Color fundus image:
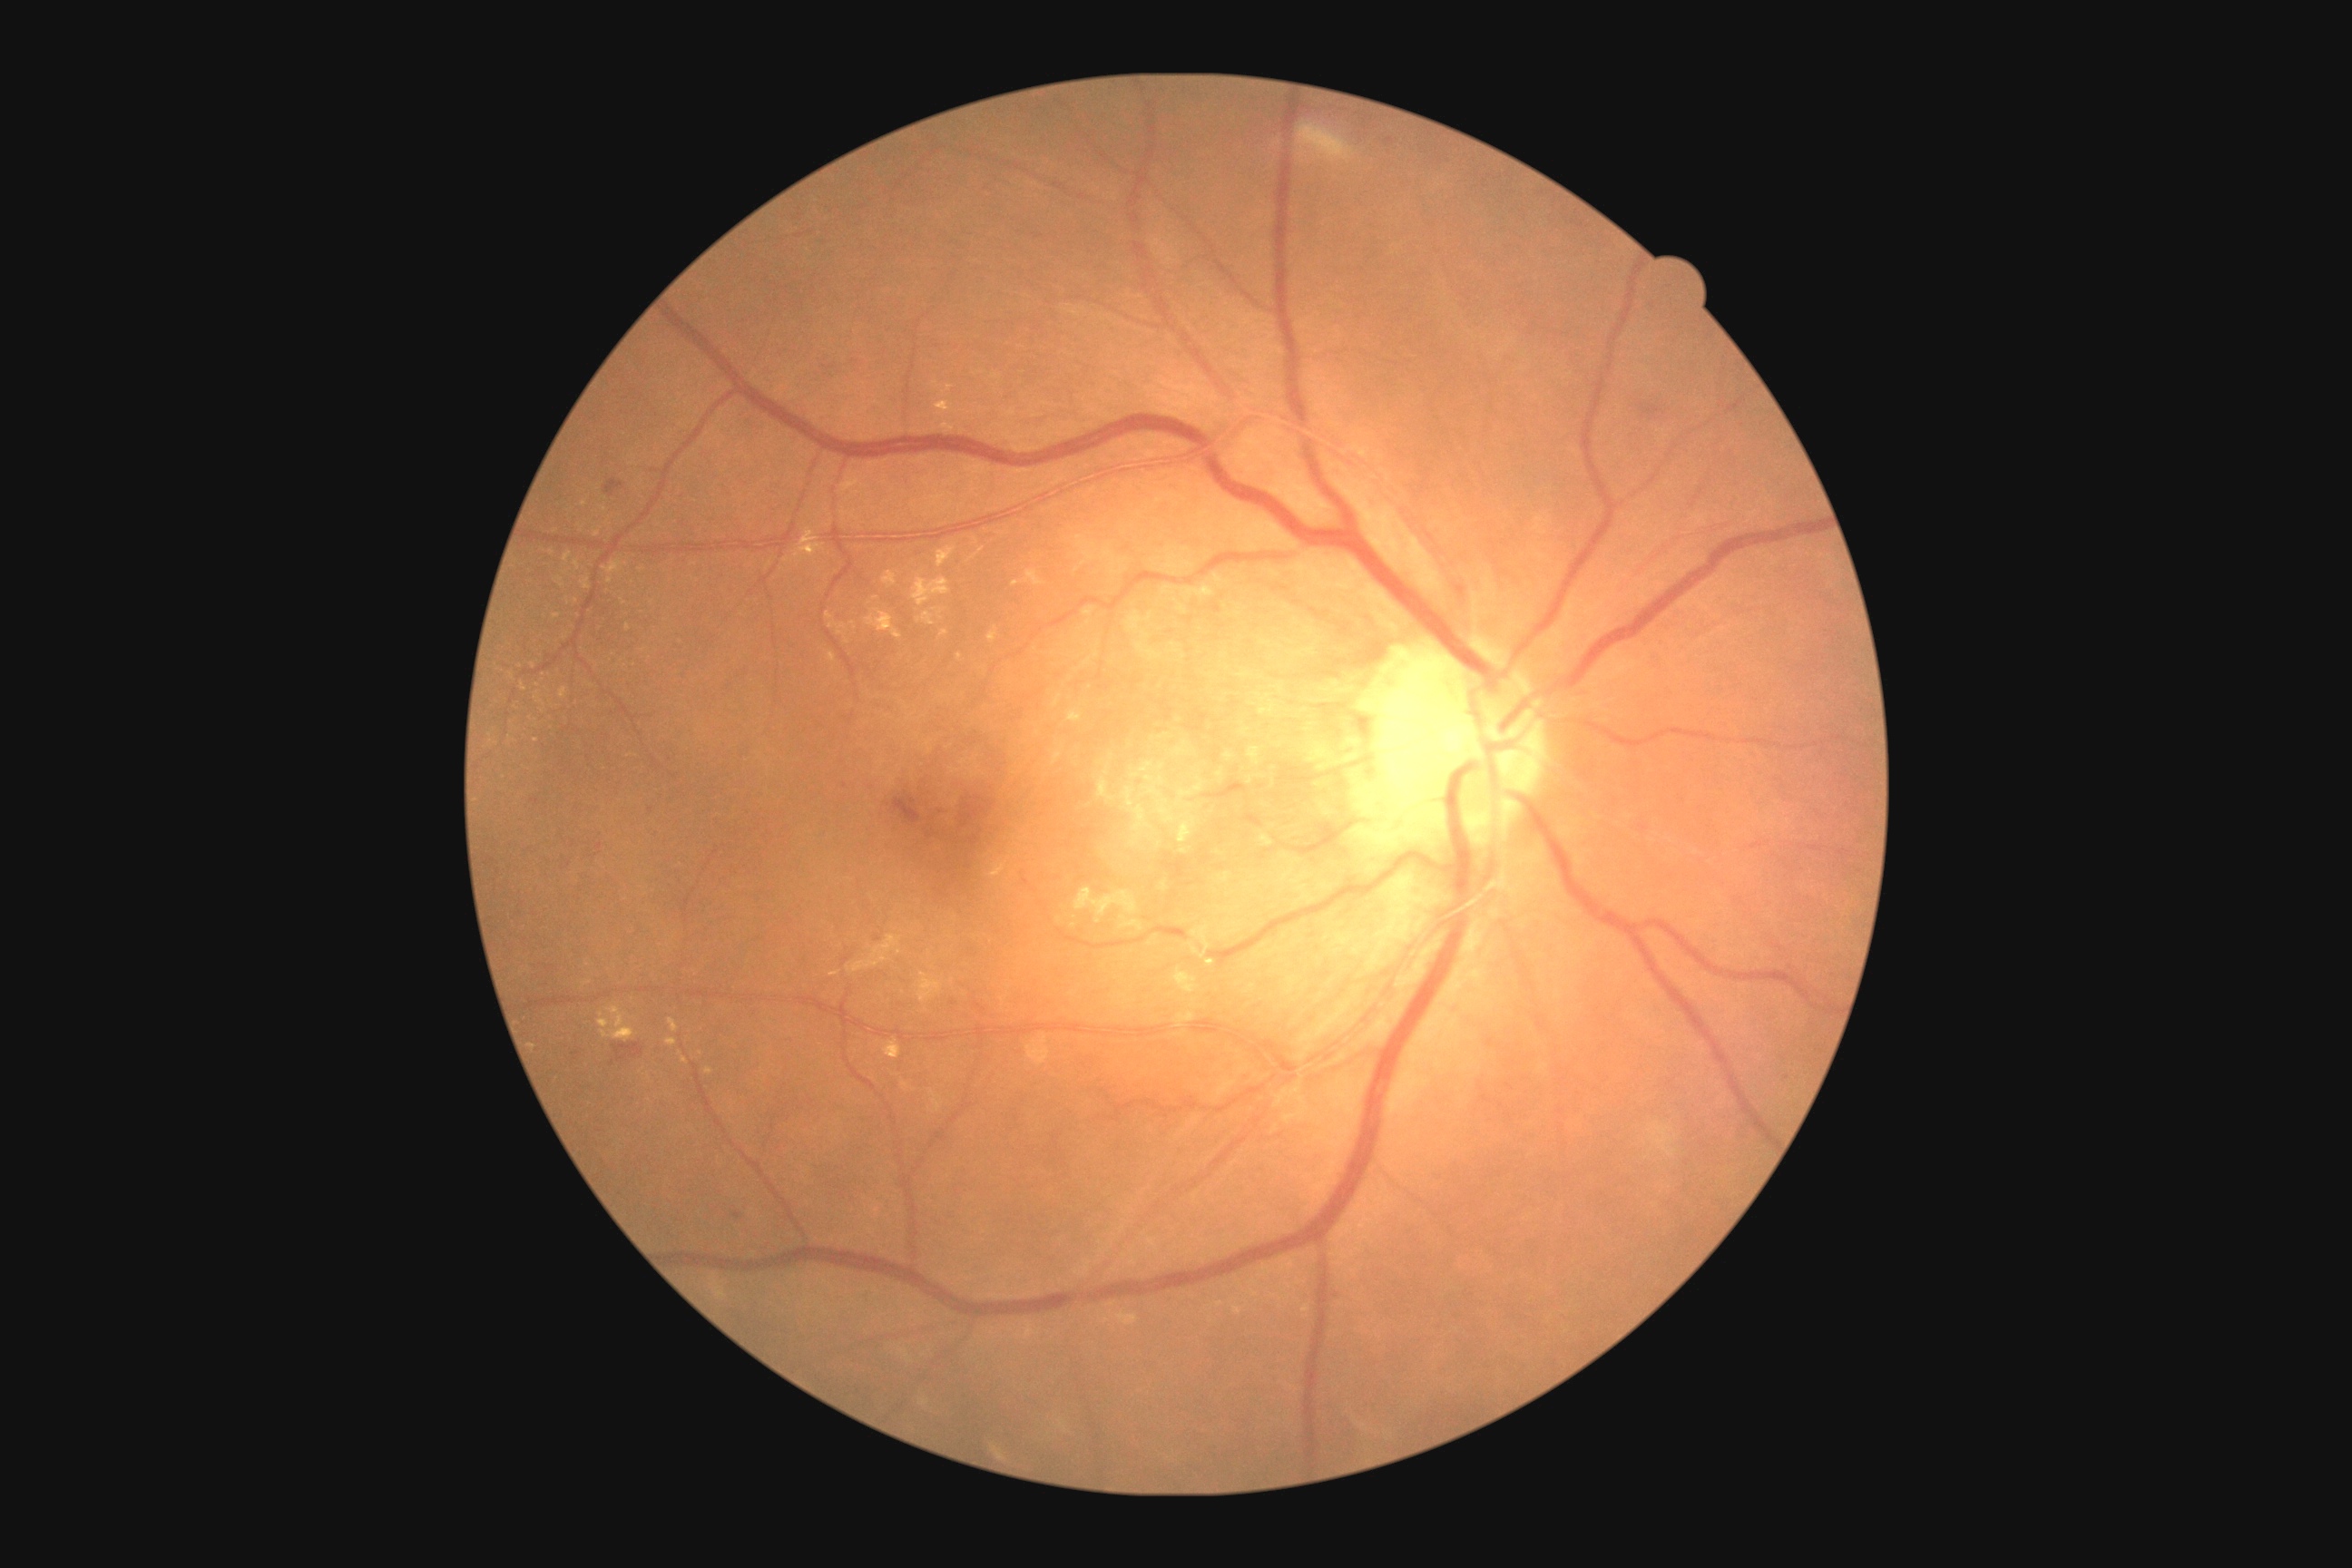

Diabetic retinopathy grade is 2 (moderate NPDR). The retinopathy is classified as non-proliferative diabetic retinopathy.